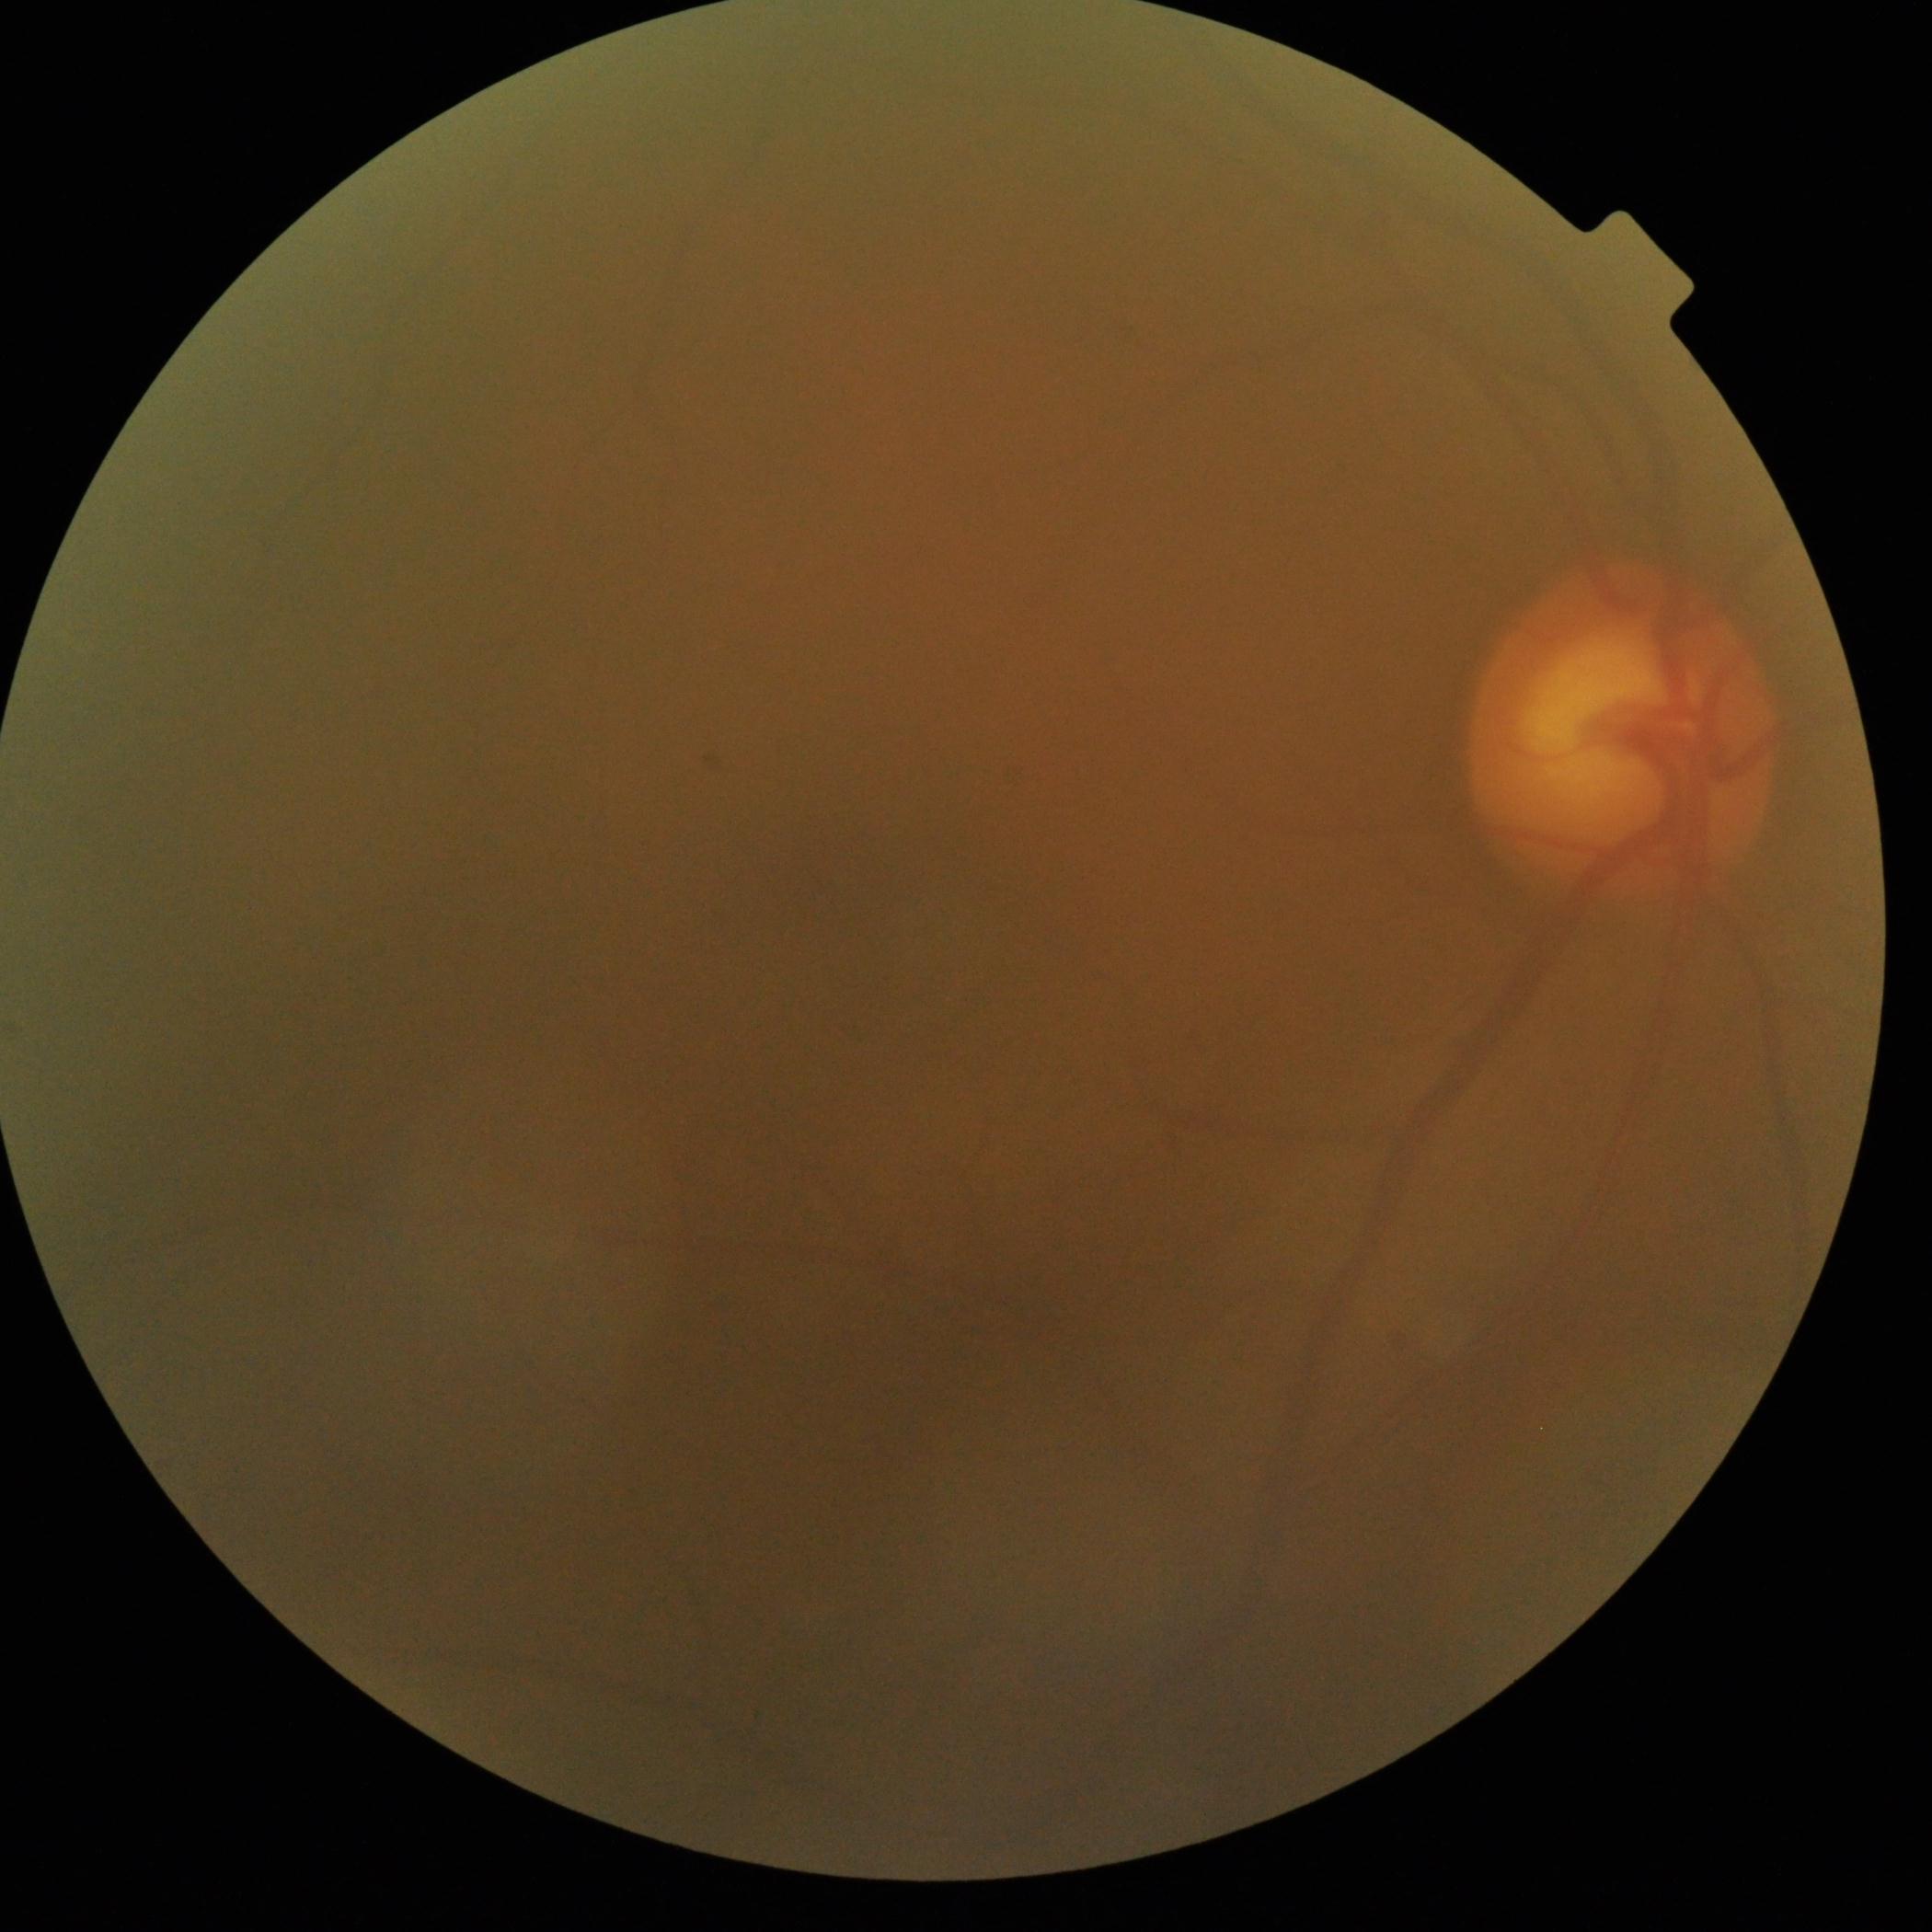

Diabetic retinopathy (DR) is grade 0 (no apparent retinopathy).